Color fundus photograph; 2184x1690px
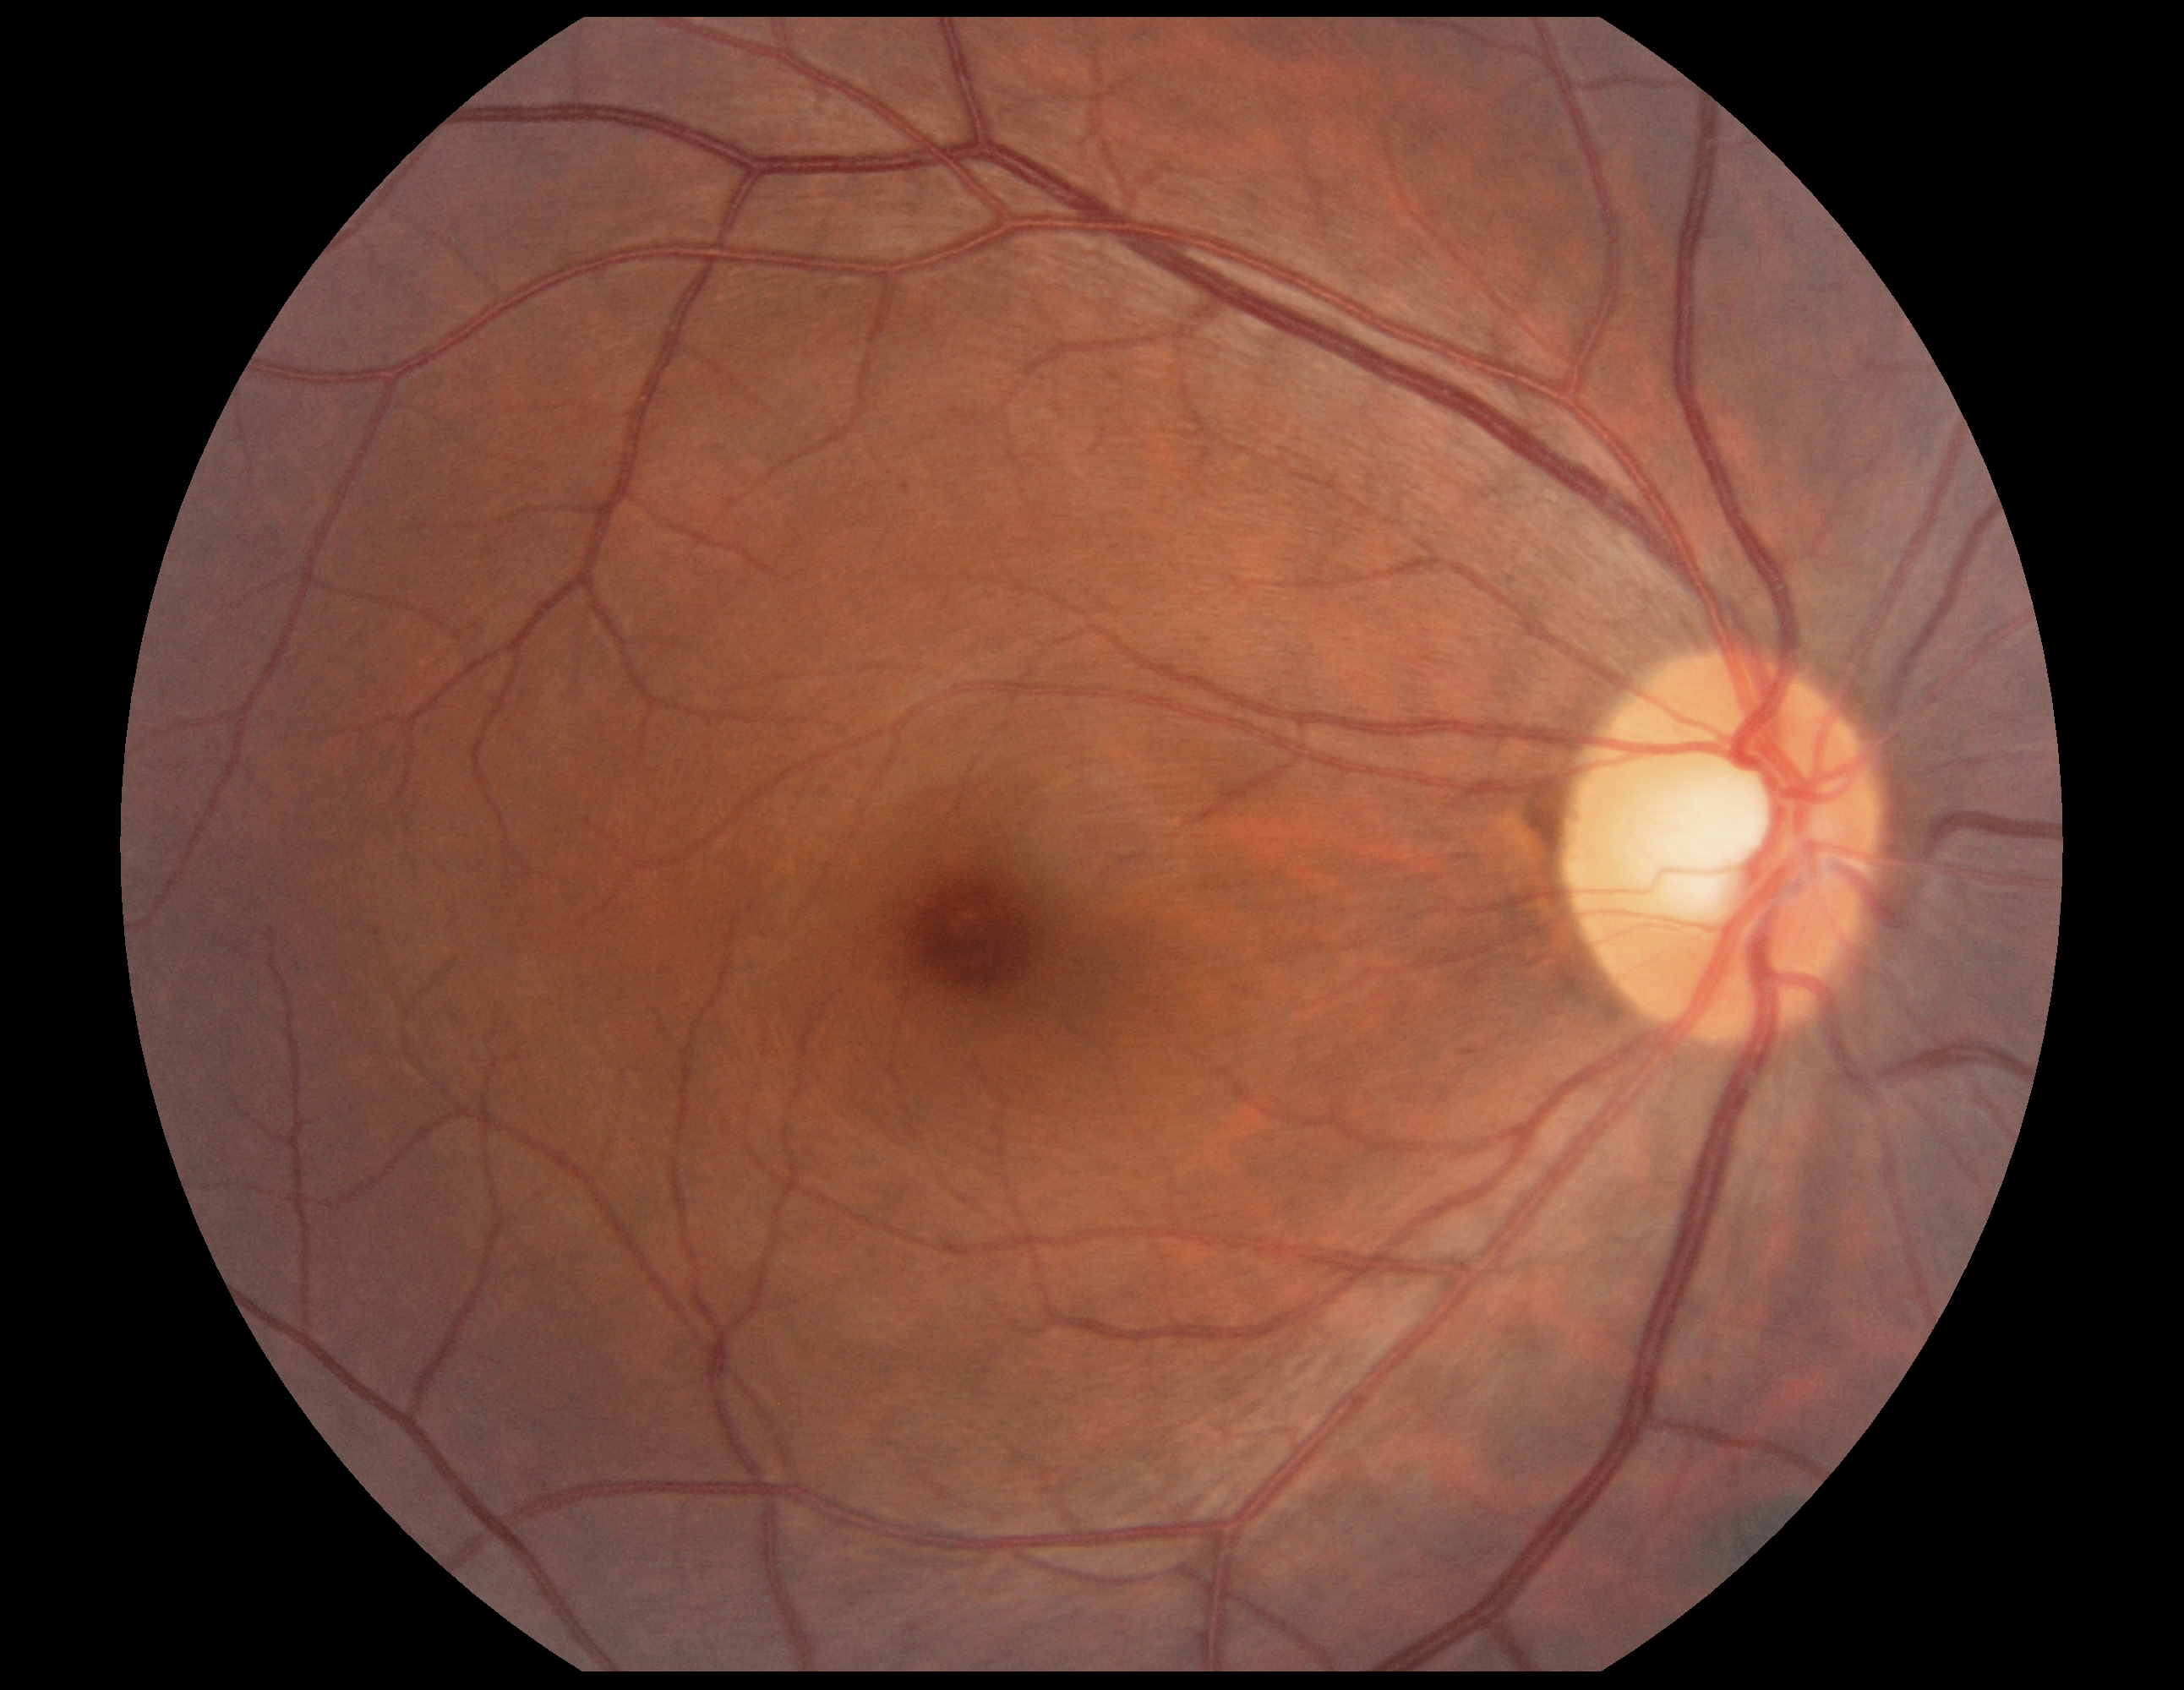 Retinopathy grade: 0.